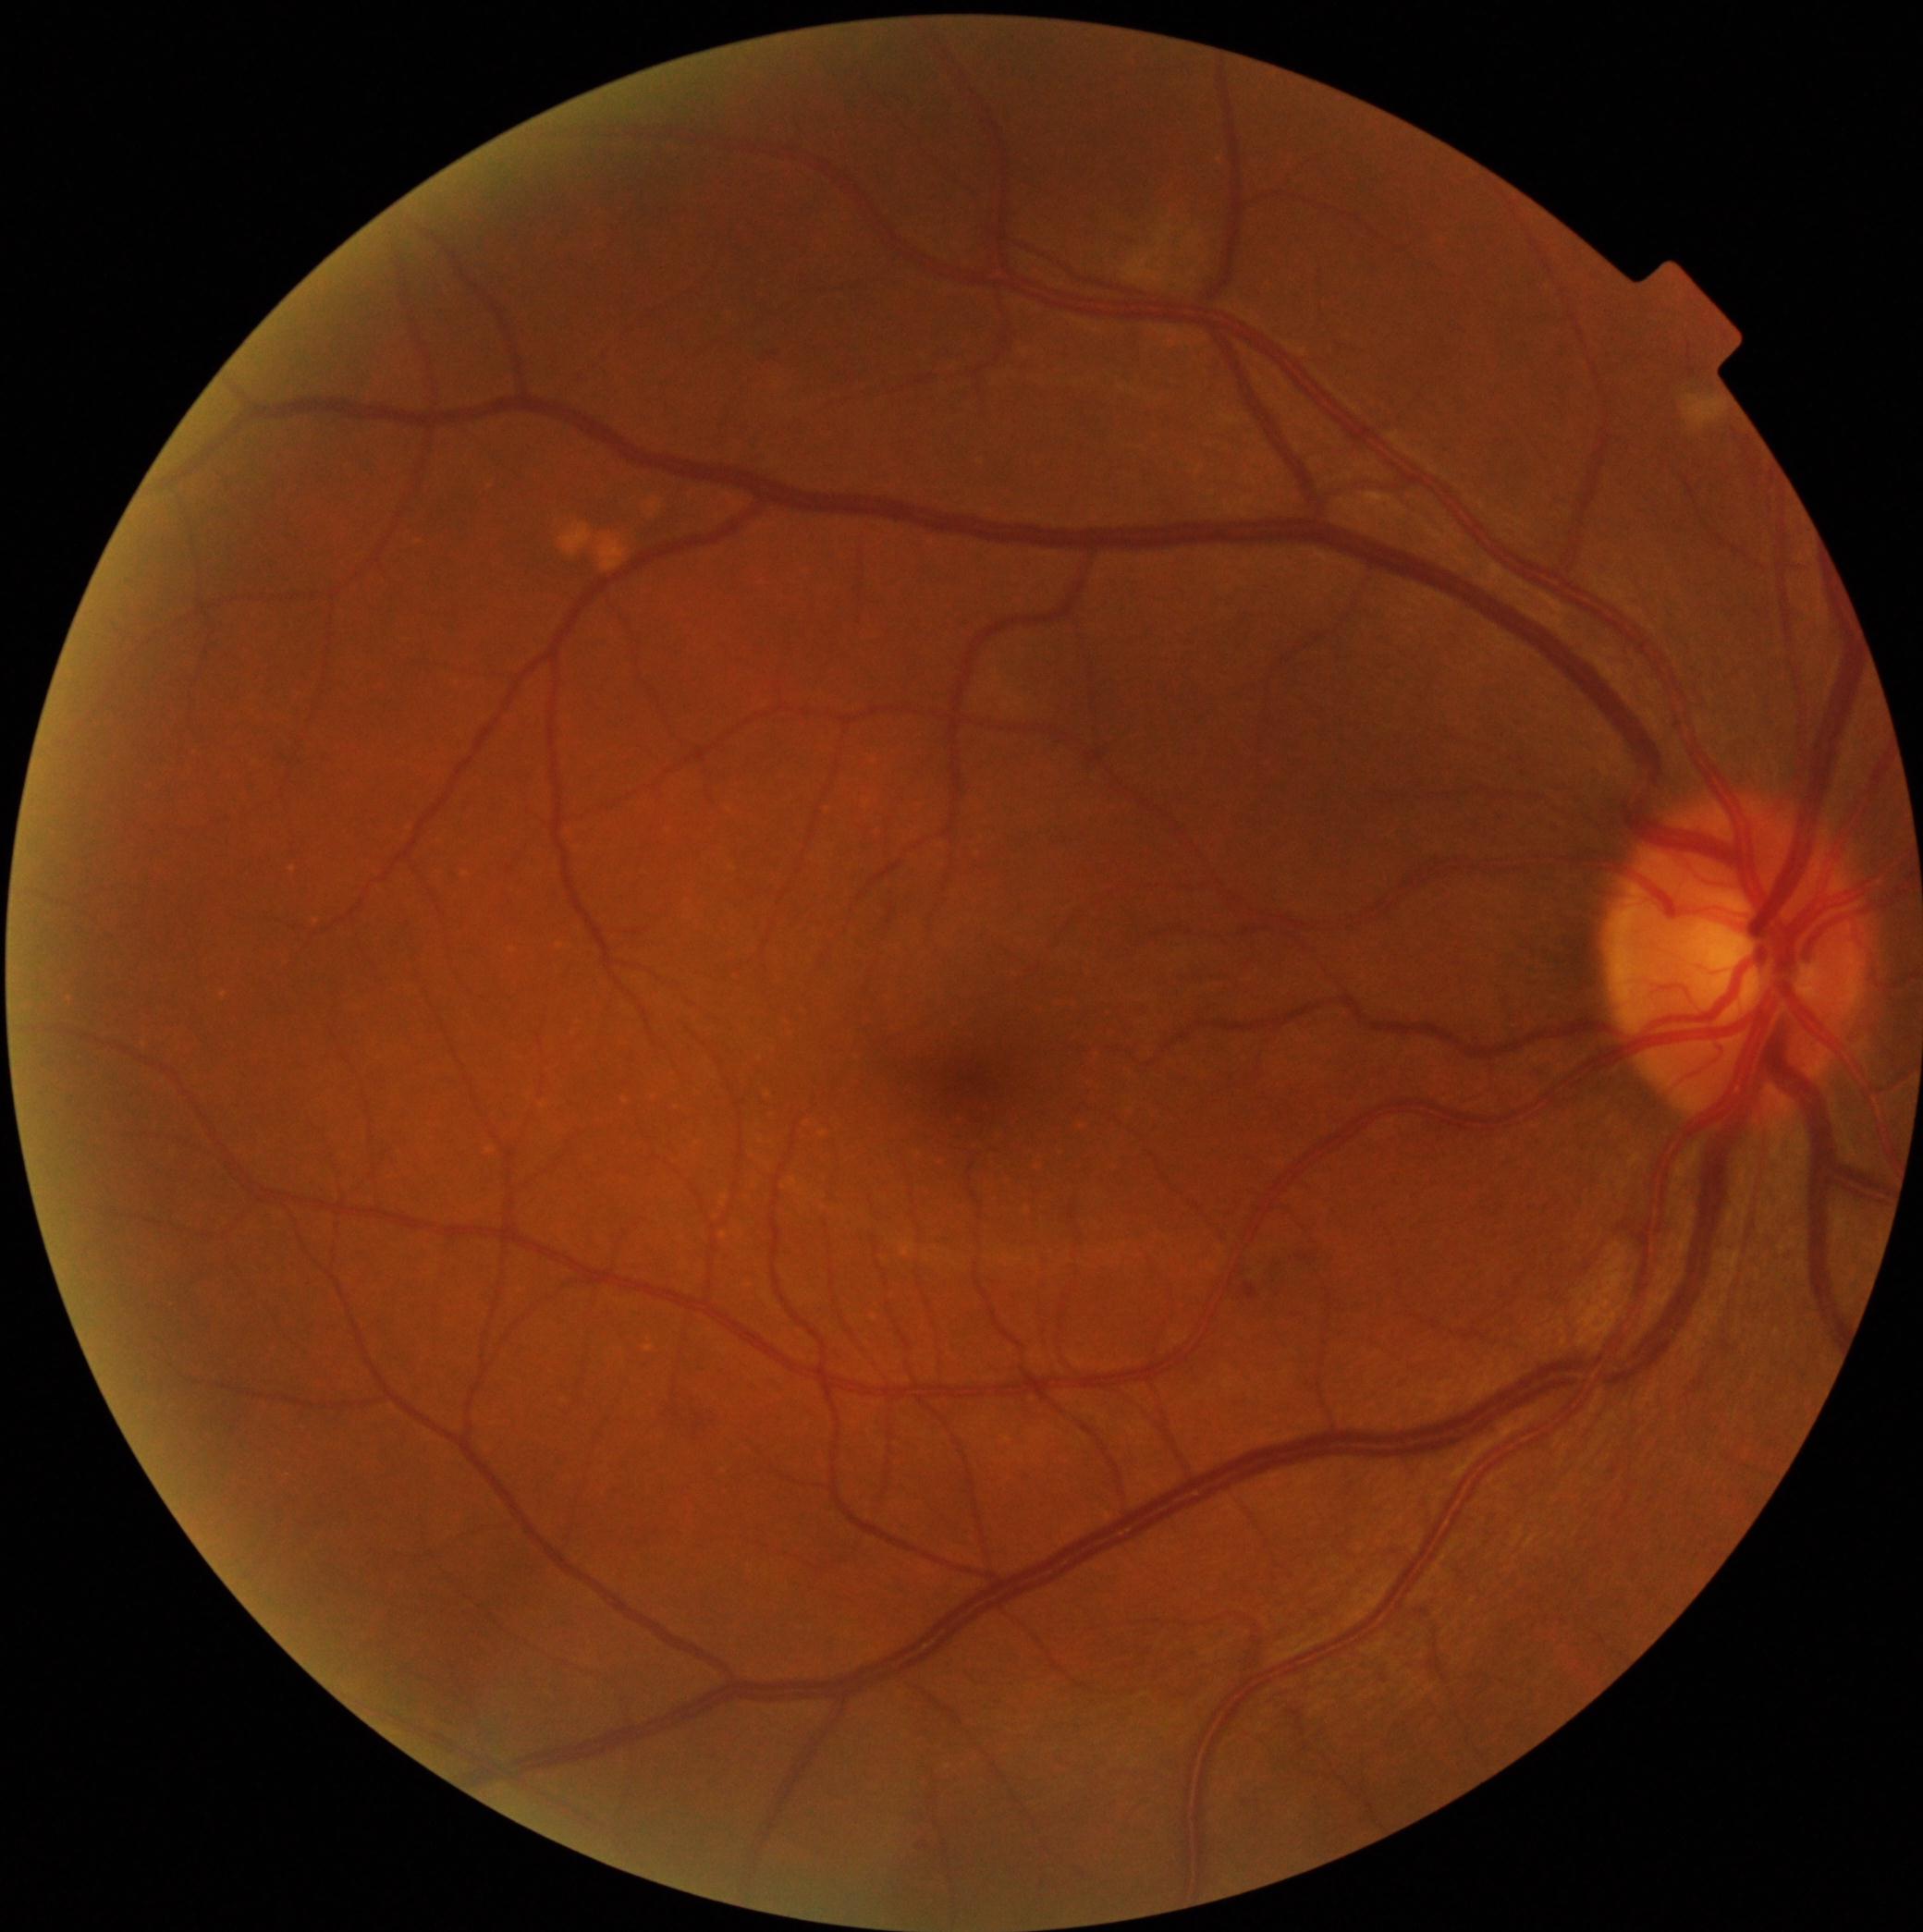 DR stage = 2.